Wide-field fundus photograph from neonatal ROP screening; 1240 x 1240 pixels.
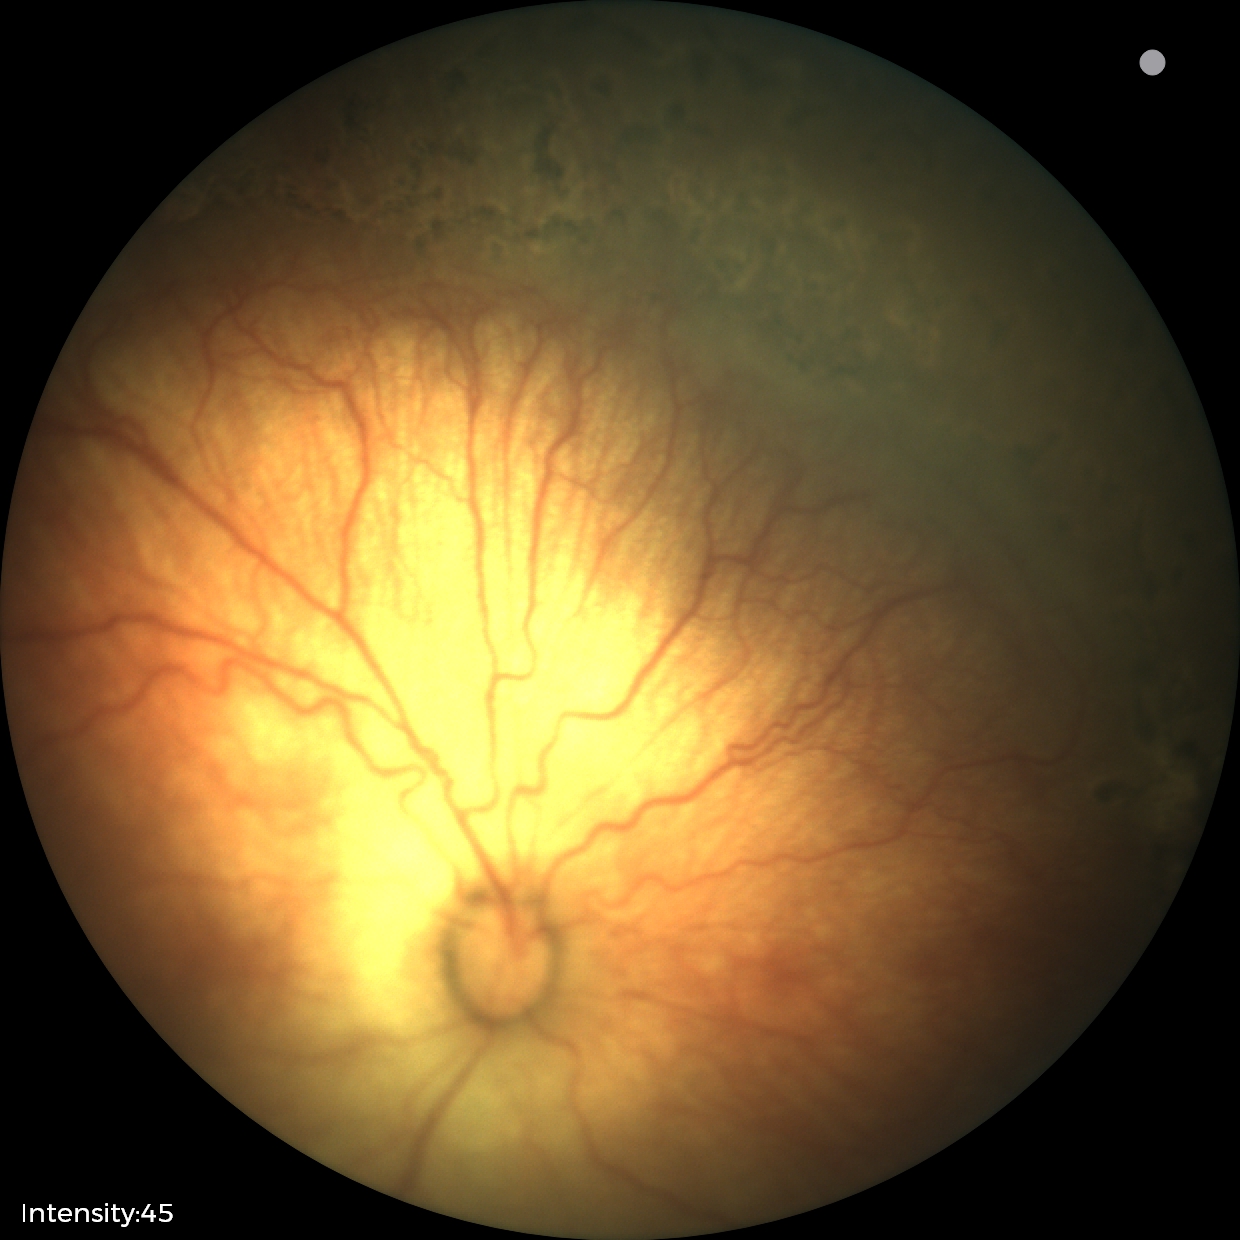
Examination diagnosed as status post ROP.